Color fundus image: 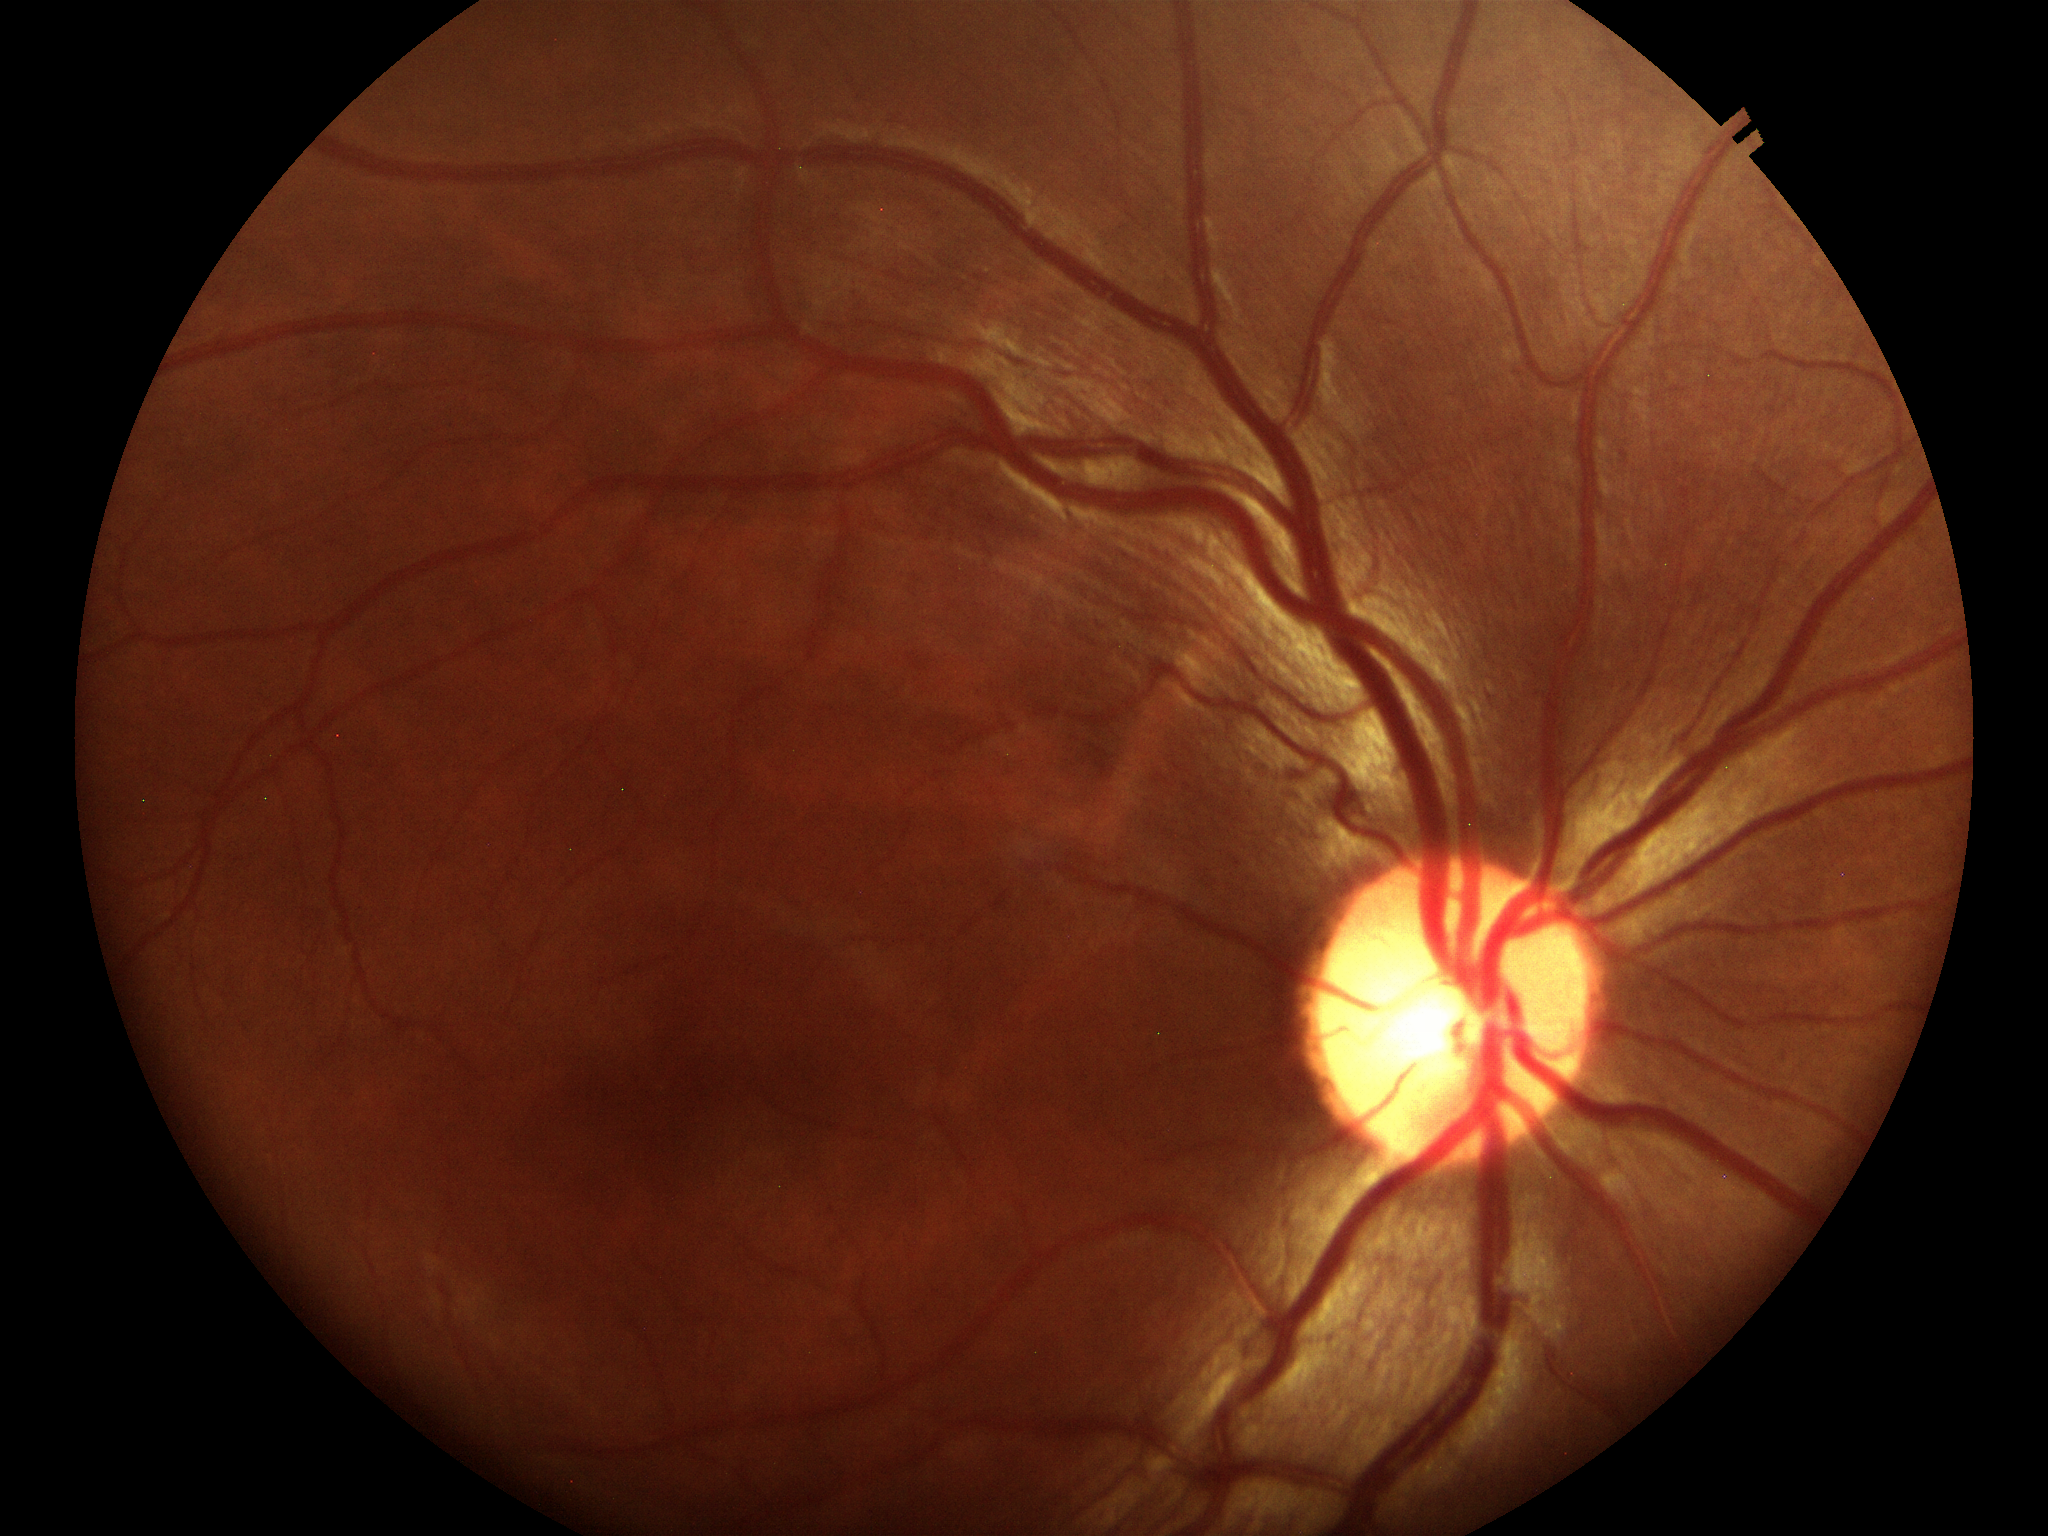 Glaucoma screening impression: negative, vertical CDR (VCDR): 0.50, horizontal cup-disc ratio (HCDR): 0.53.